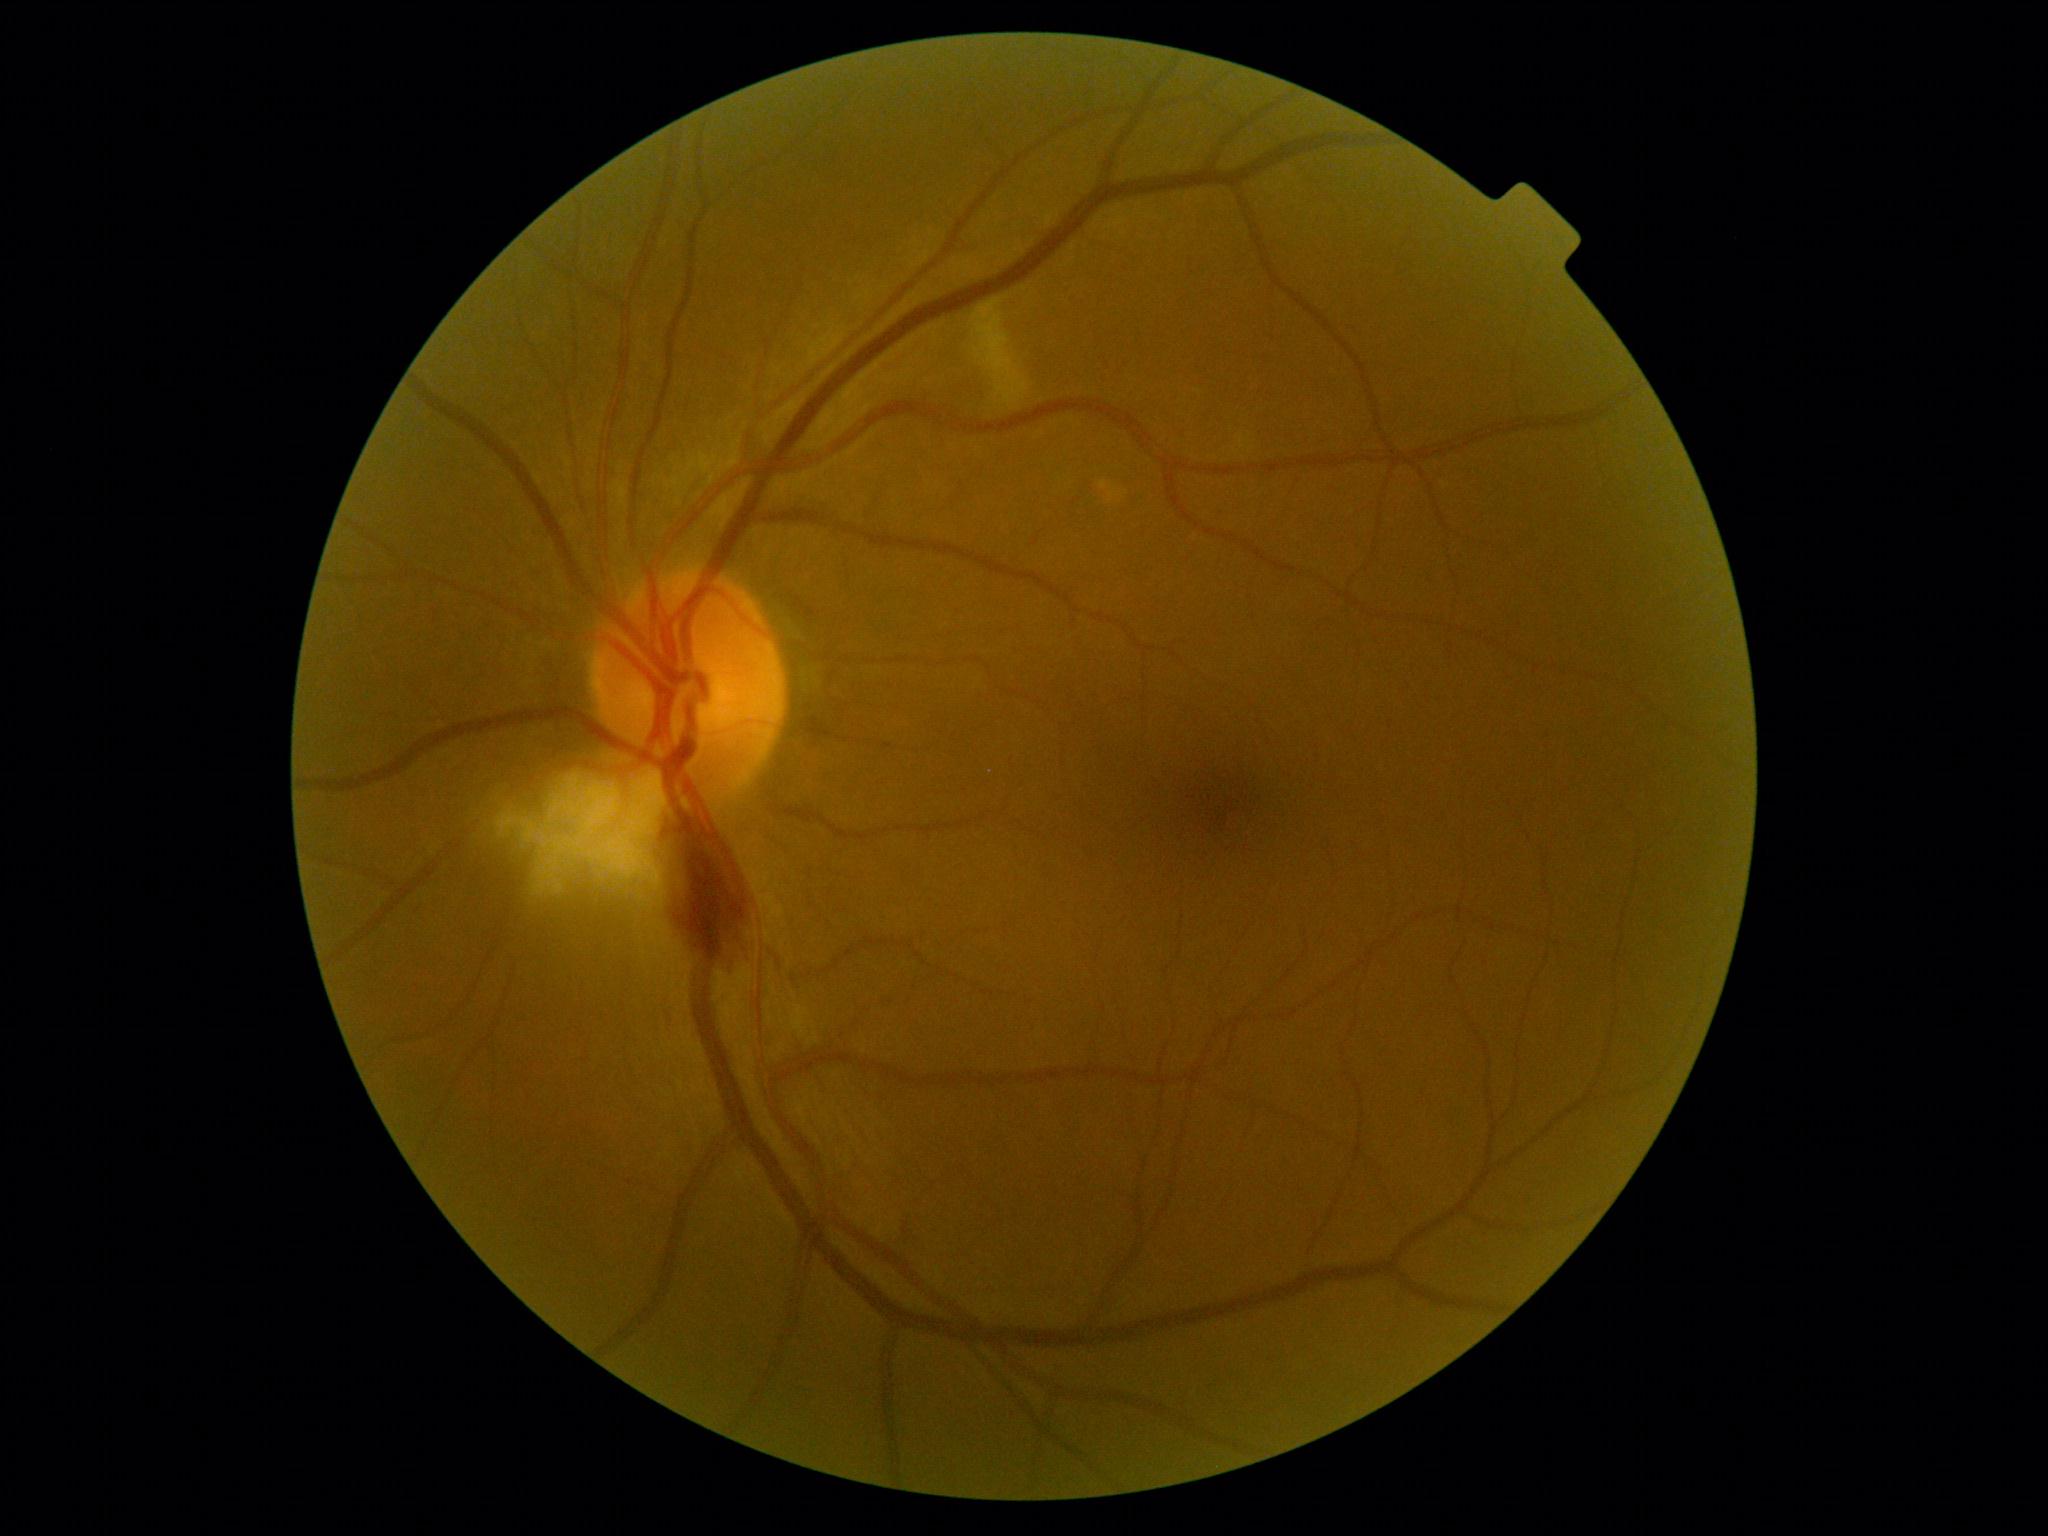

Diabetic retinopathy (DR): grade 2 — more than just microaneurysms but less than severe NPDR.